45° field of view:
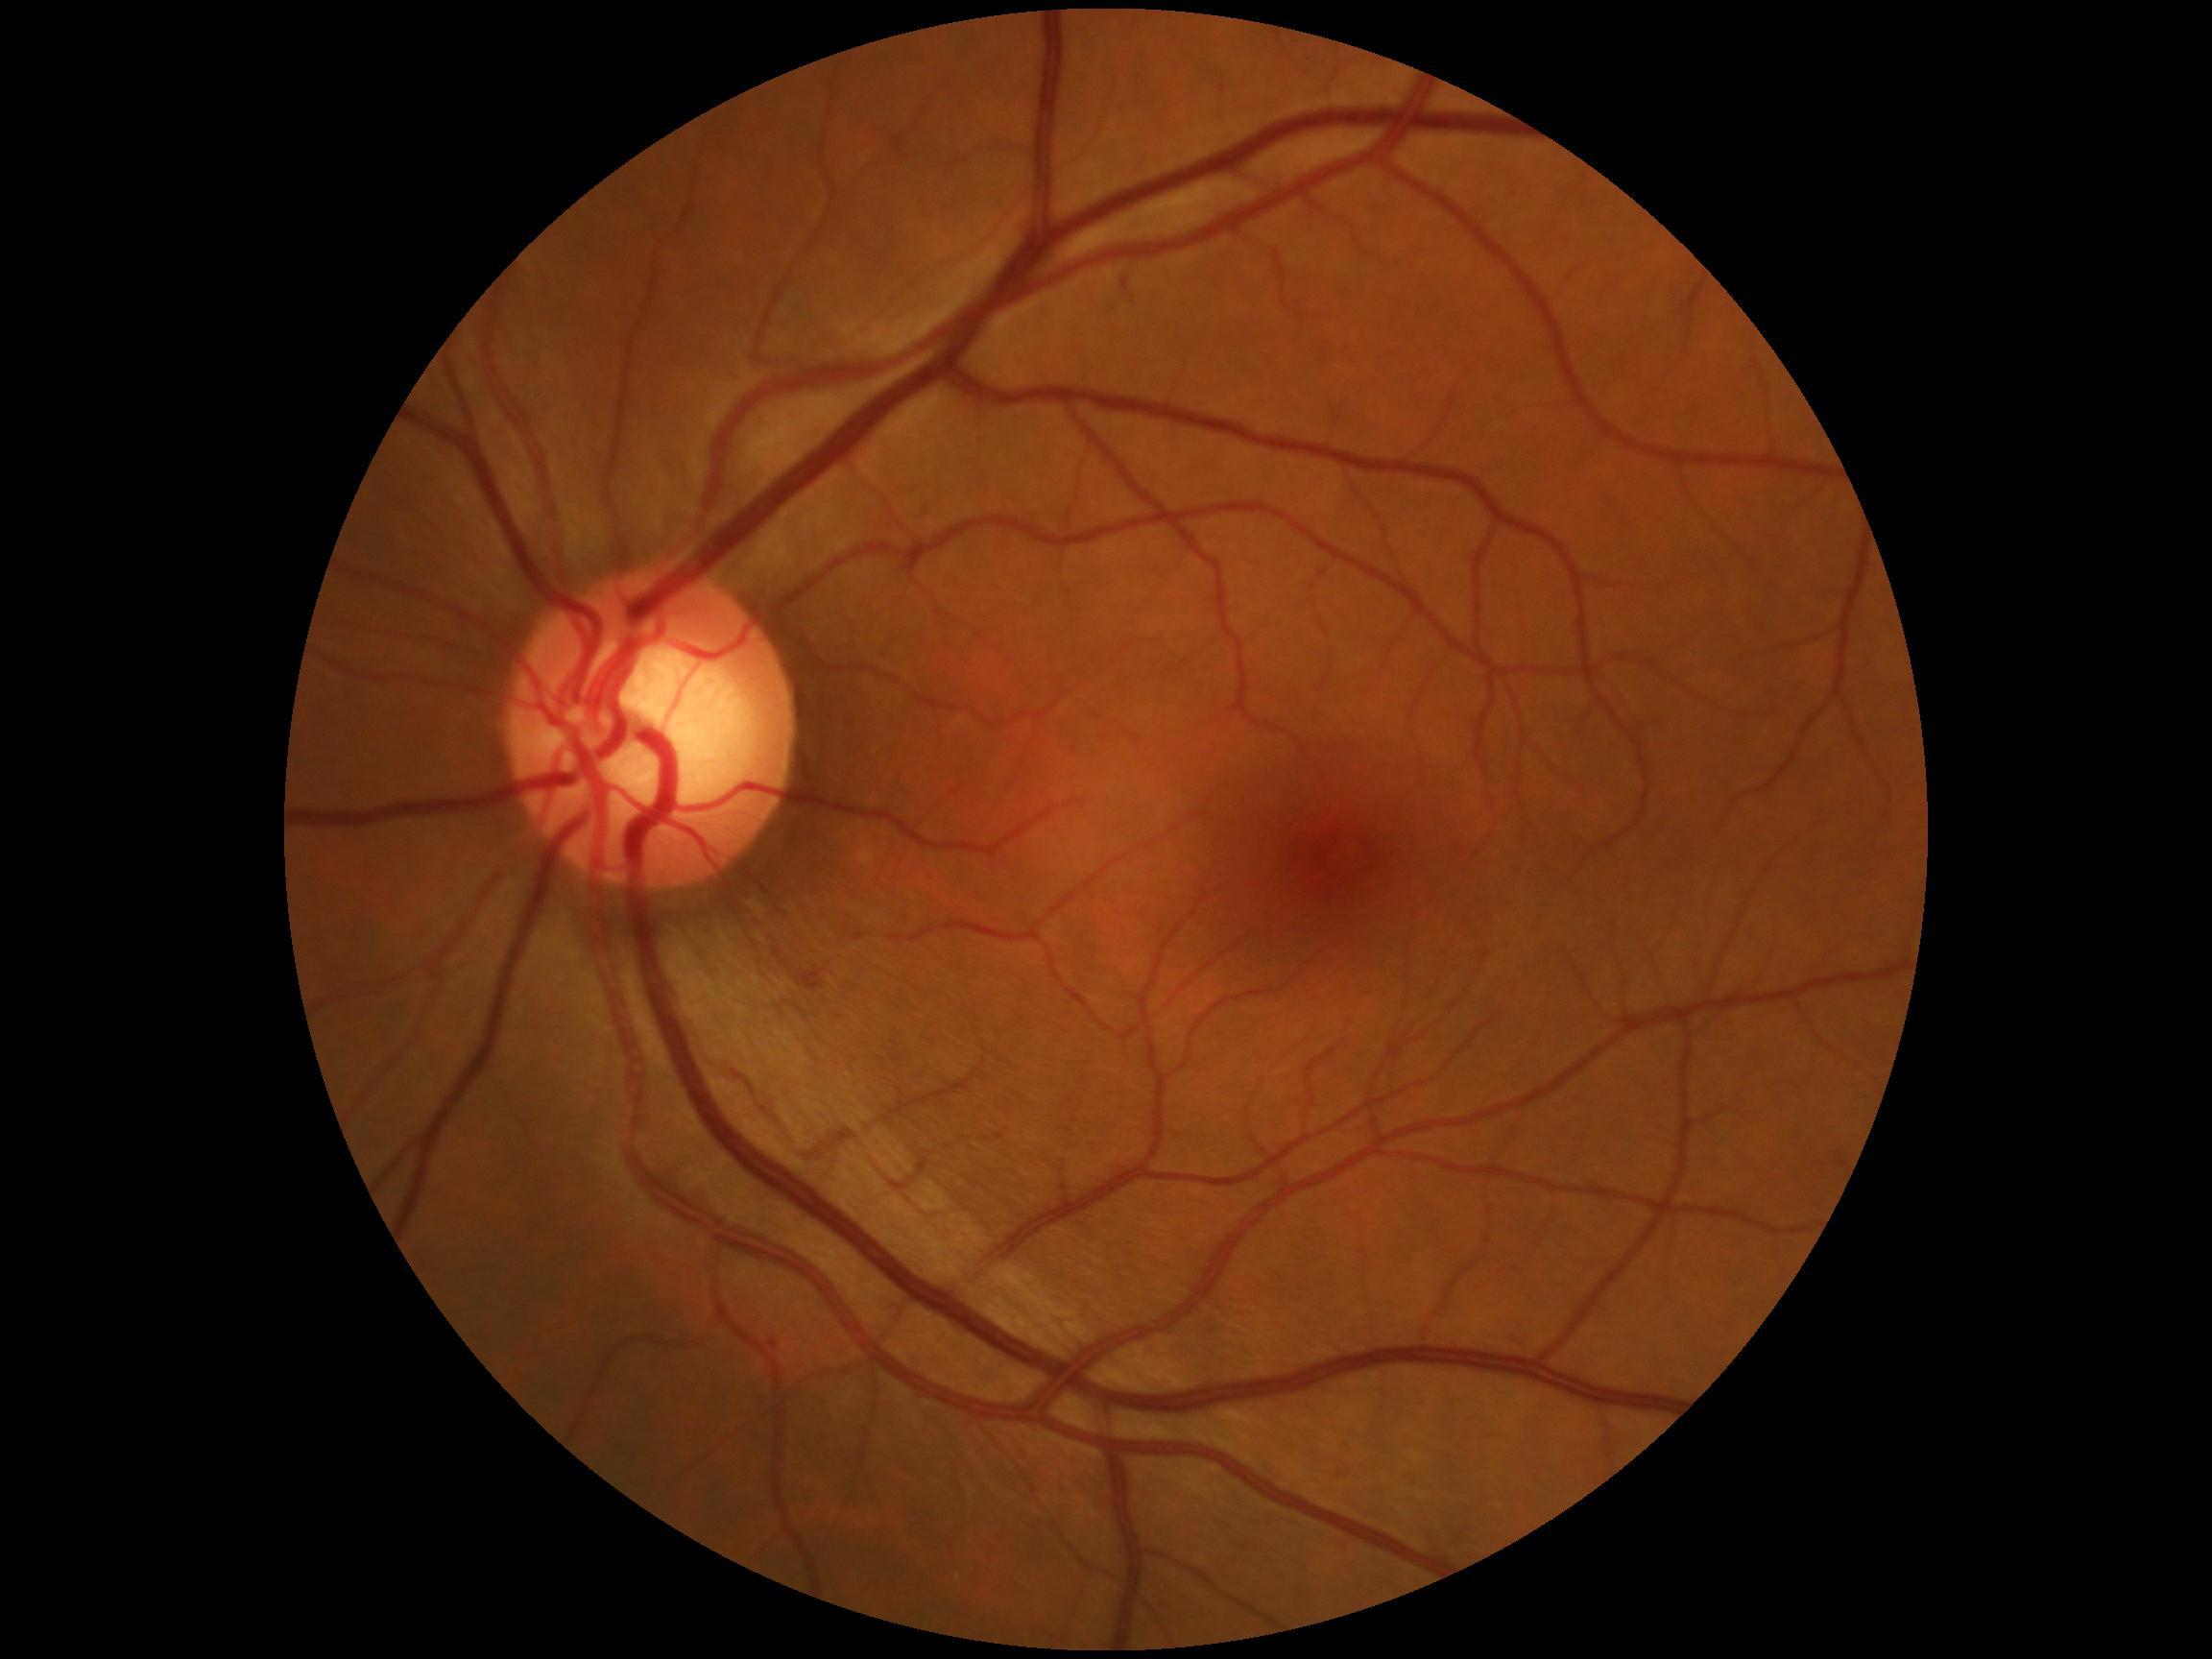 Findings:
* diabetic retinopathy (DR): 1